45-degree field of view; 2048x1536; color fundus photograph
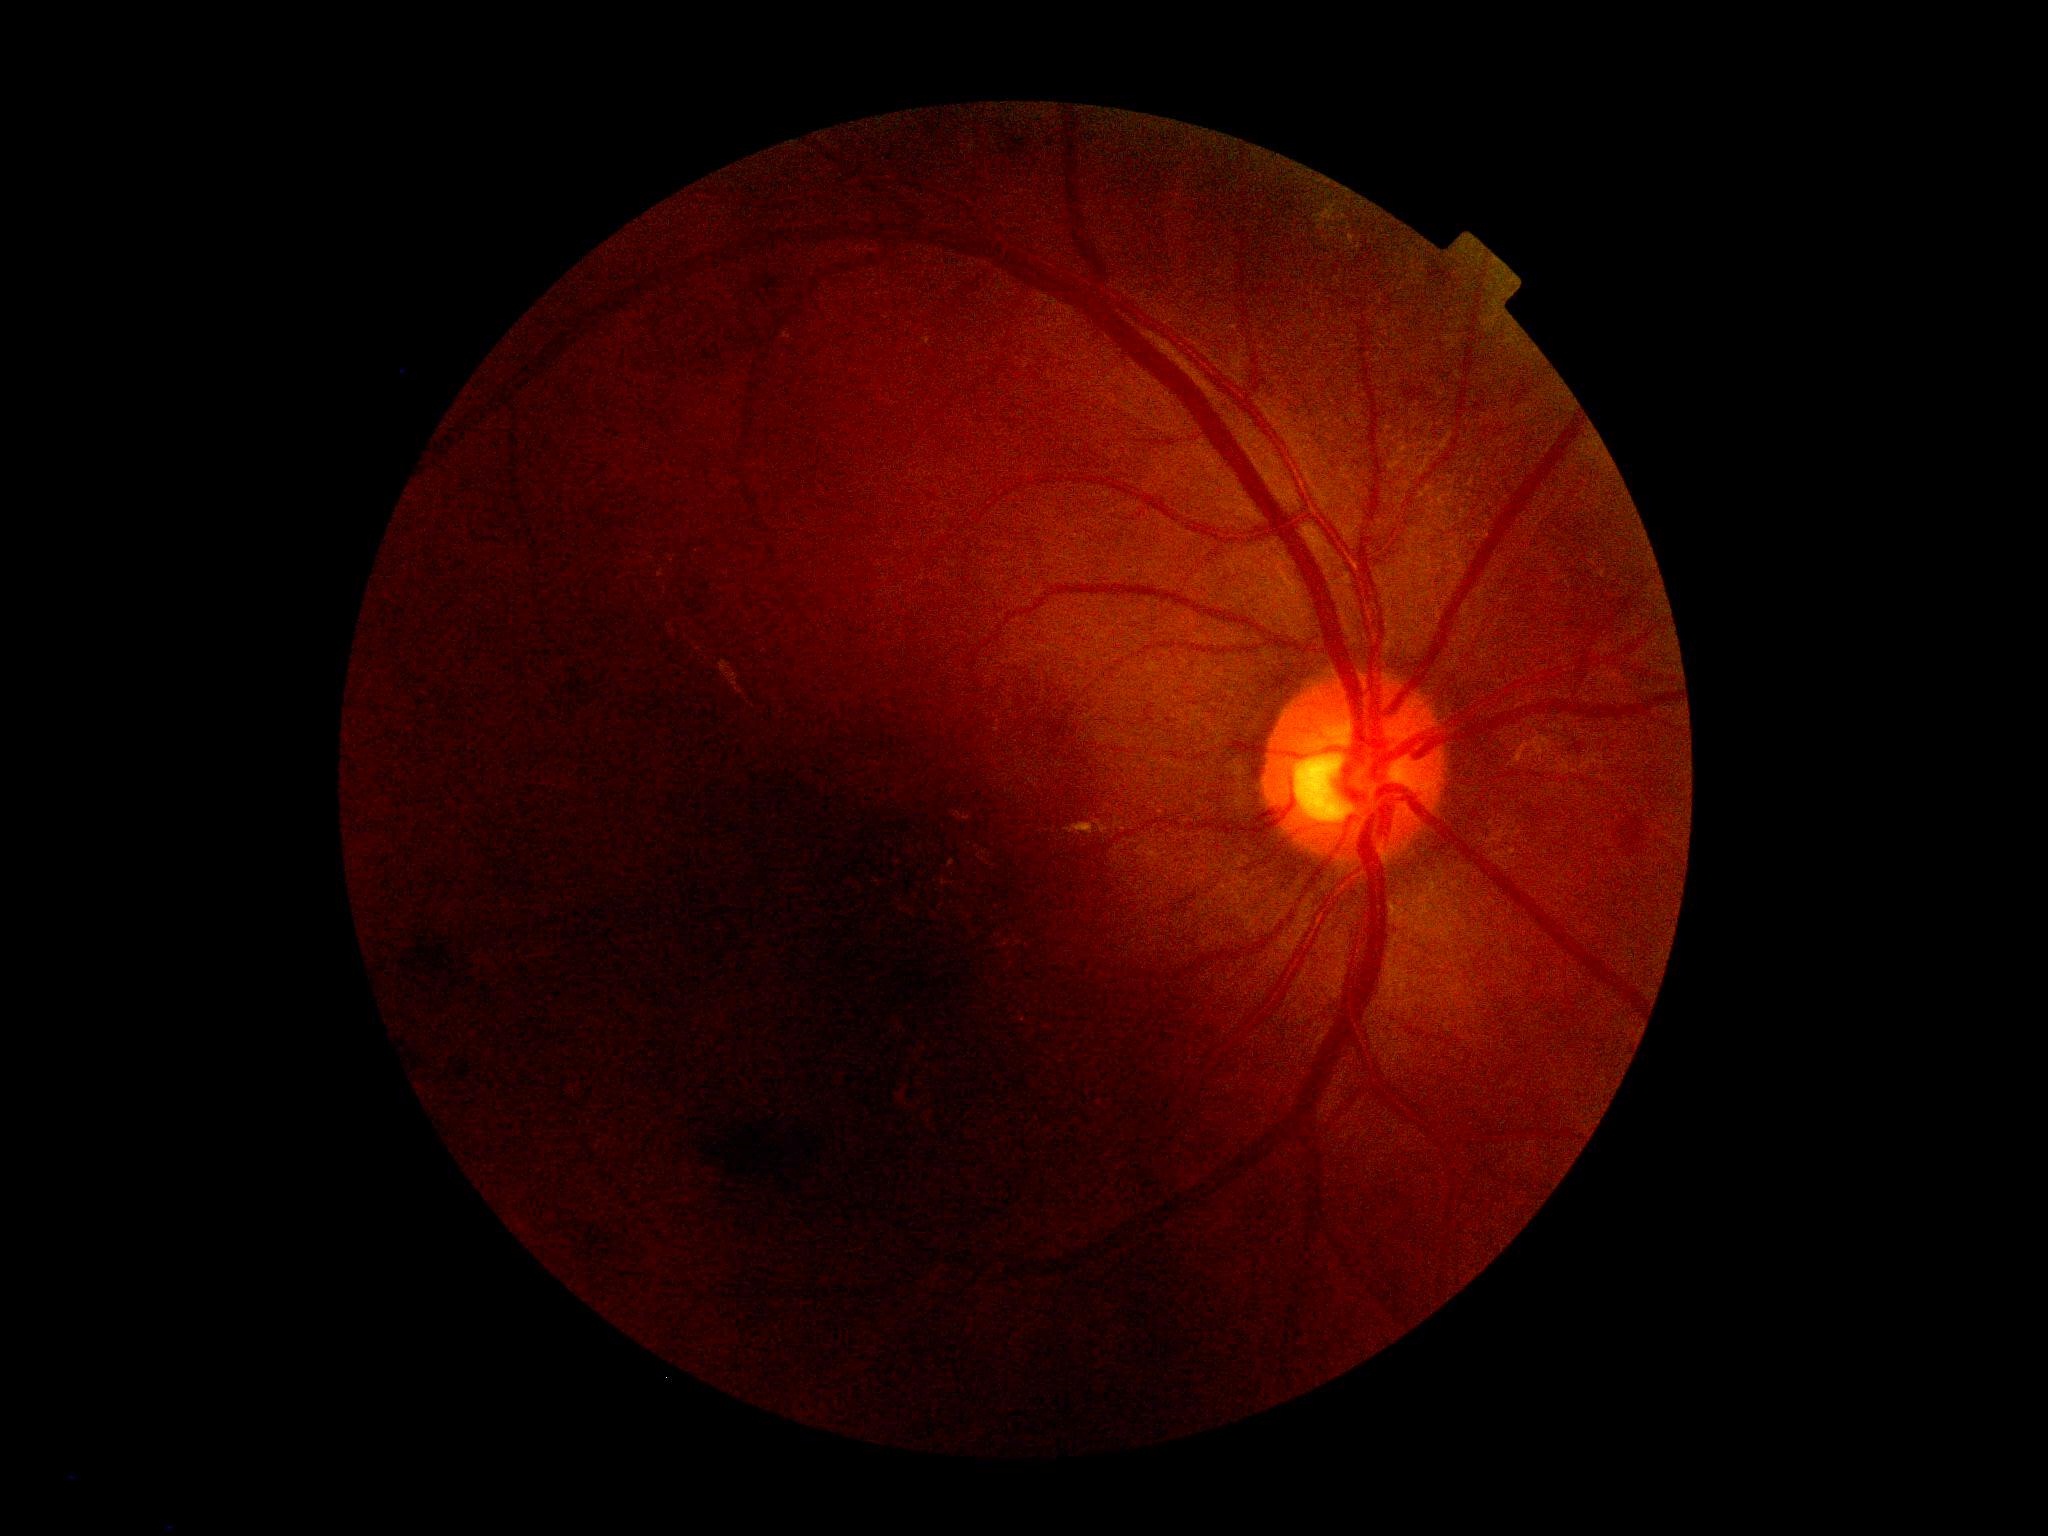
{
  "dr_grade": "2/4"
}